Fundus photo, 45 degree fundus photograph
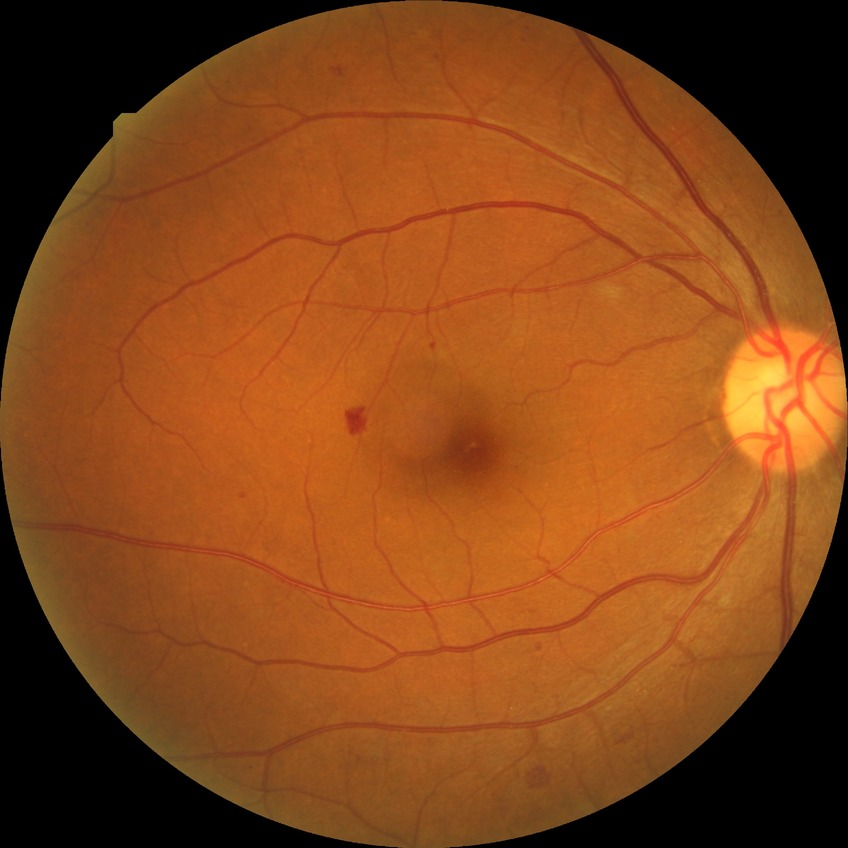
diabetic retinopathy (DR): simple diabetic retinopathy (SDR).